Color fundus image · 2352x1568px · FOV: 45 degrees.
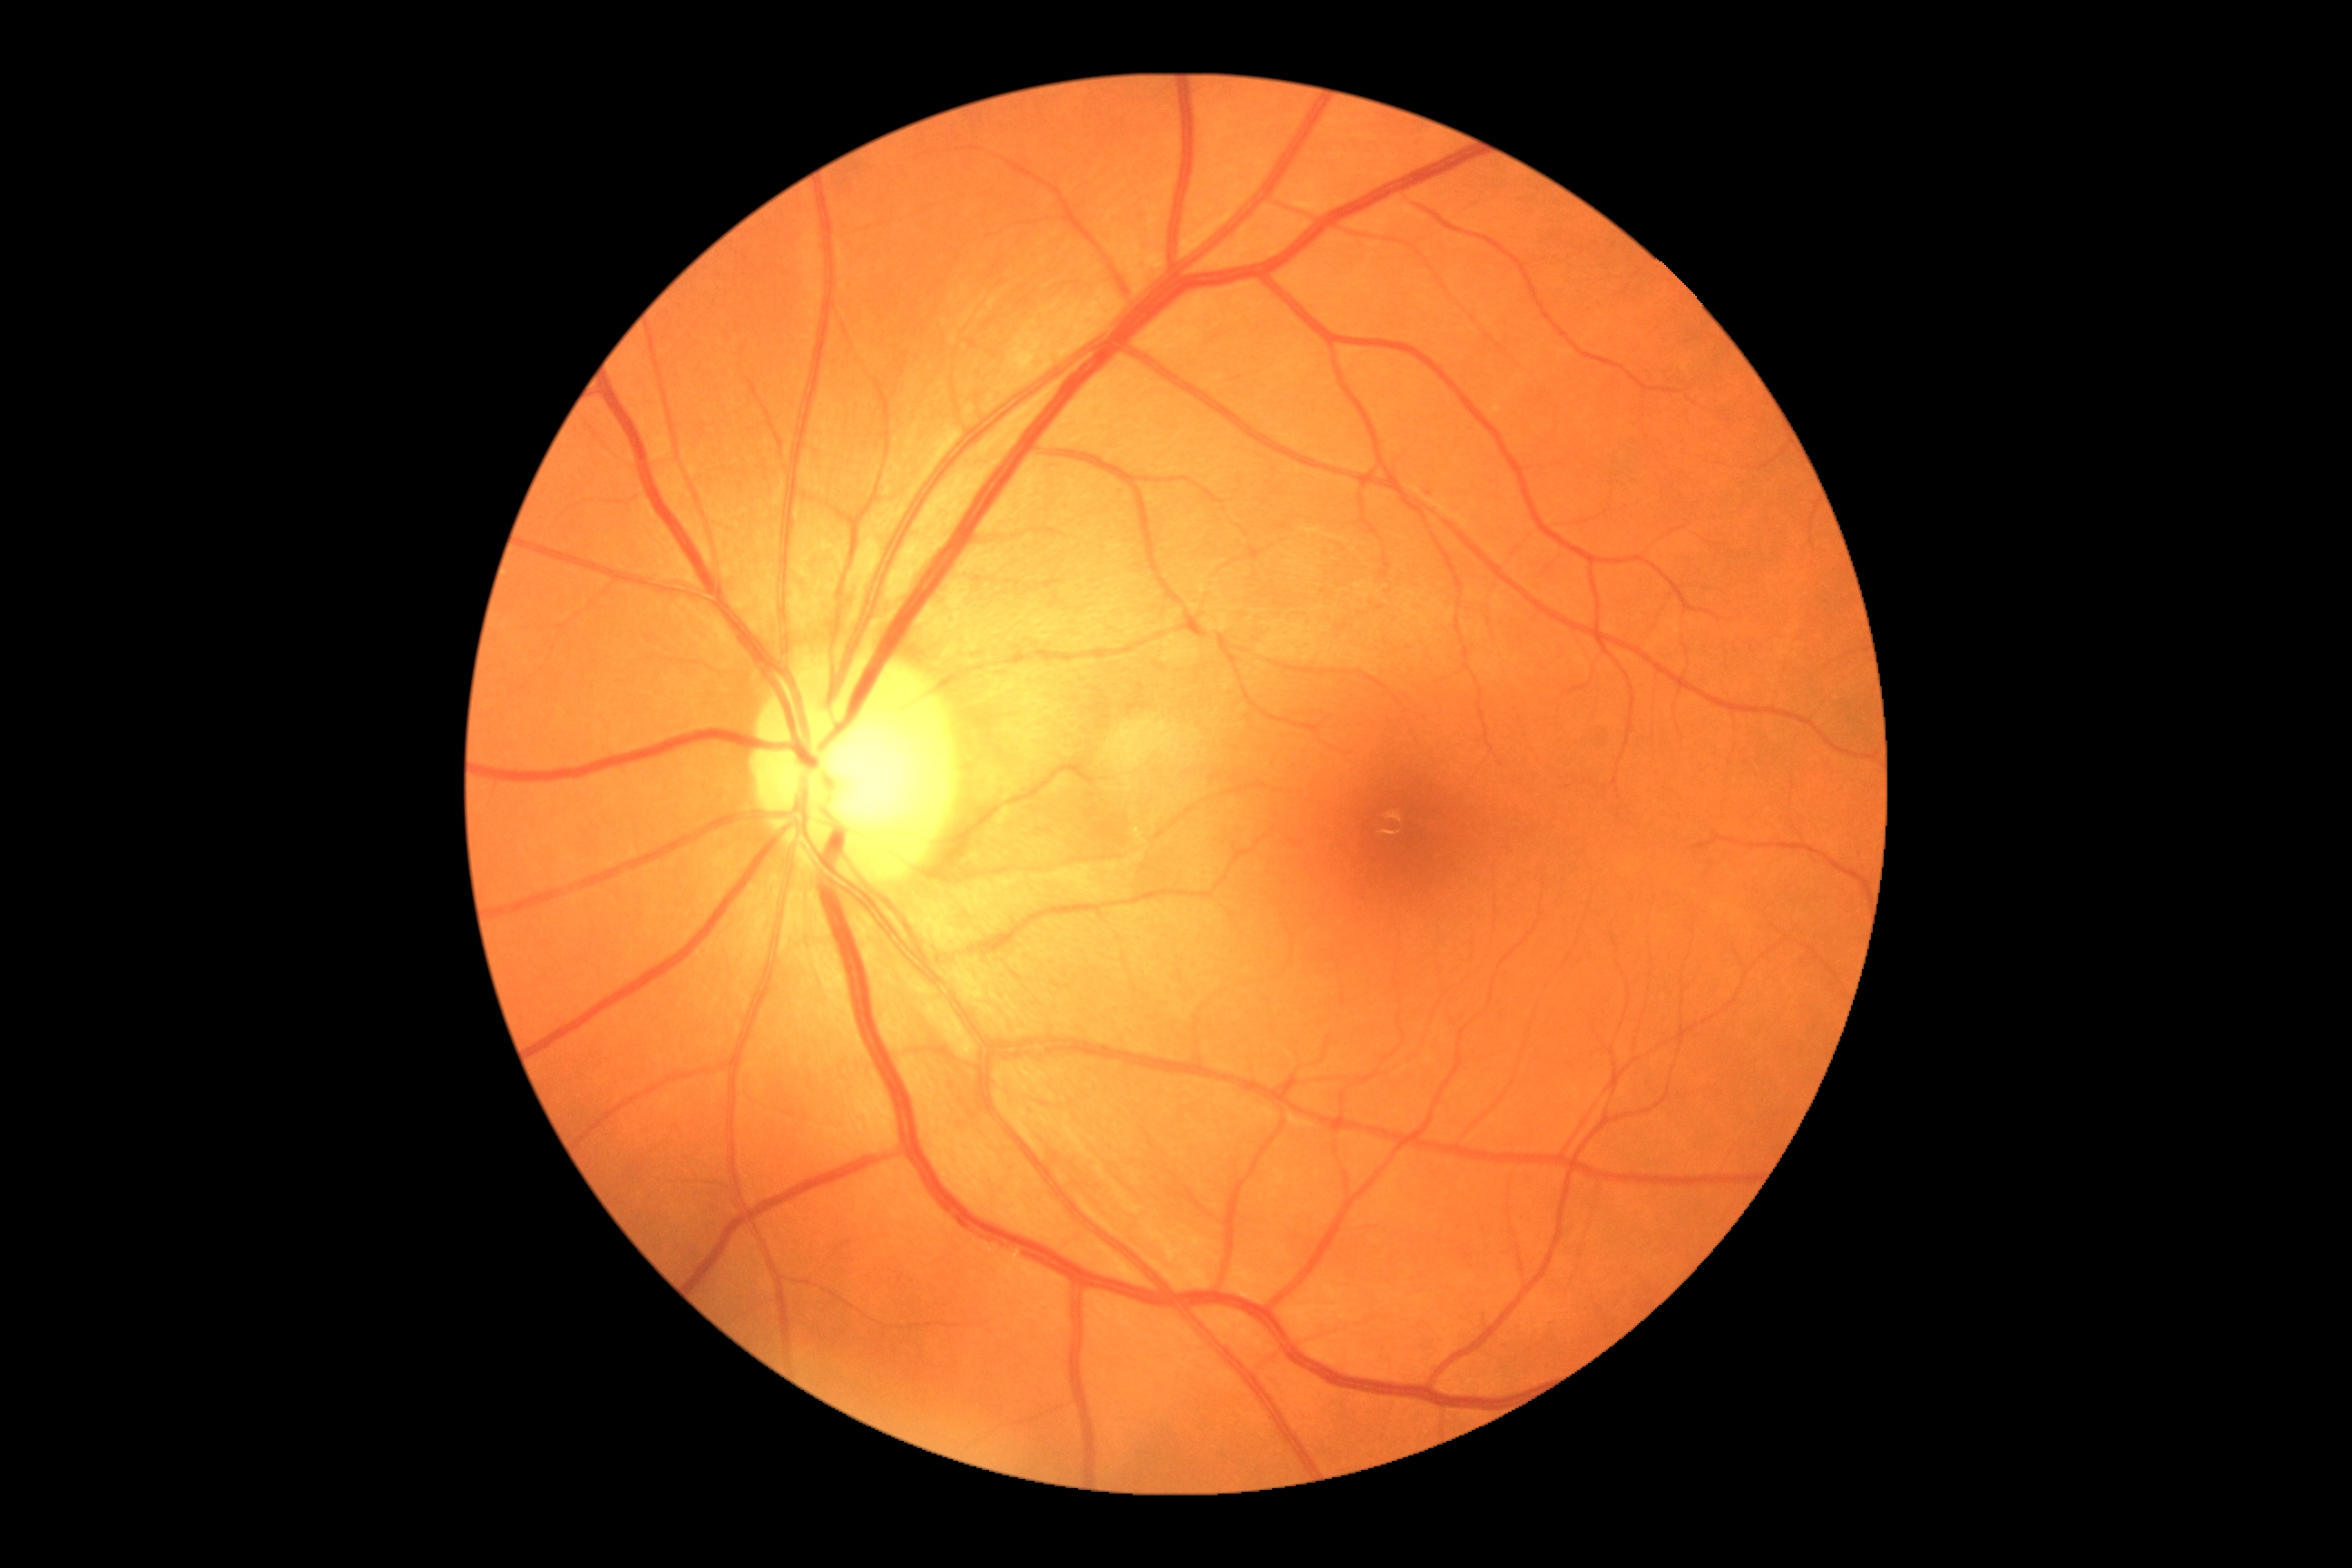

{
  "dr_impression": "negative for DR",
  "dr_grade": "0"
}